Wide-field fundus image from infant ROP screening
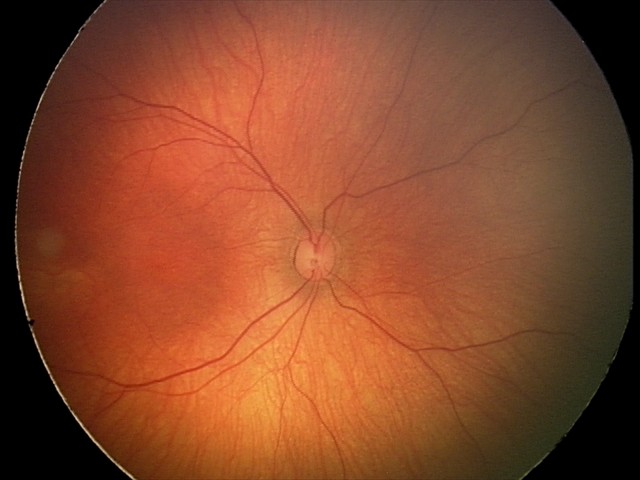

No retinal pathology identified on screening.